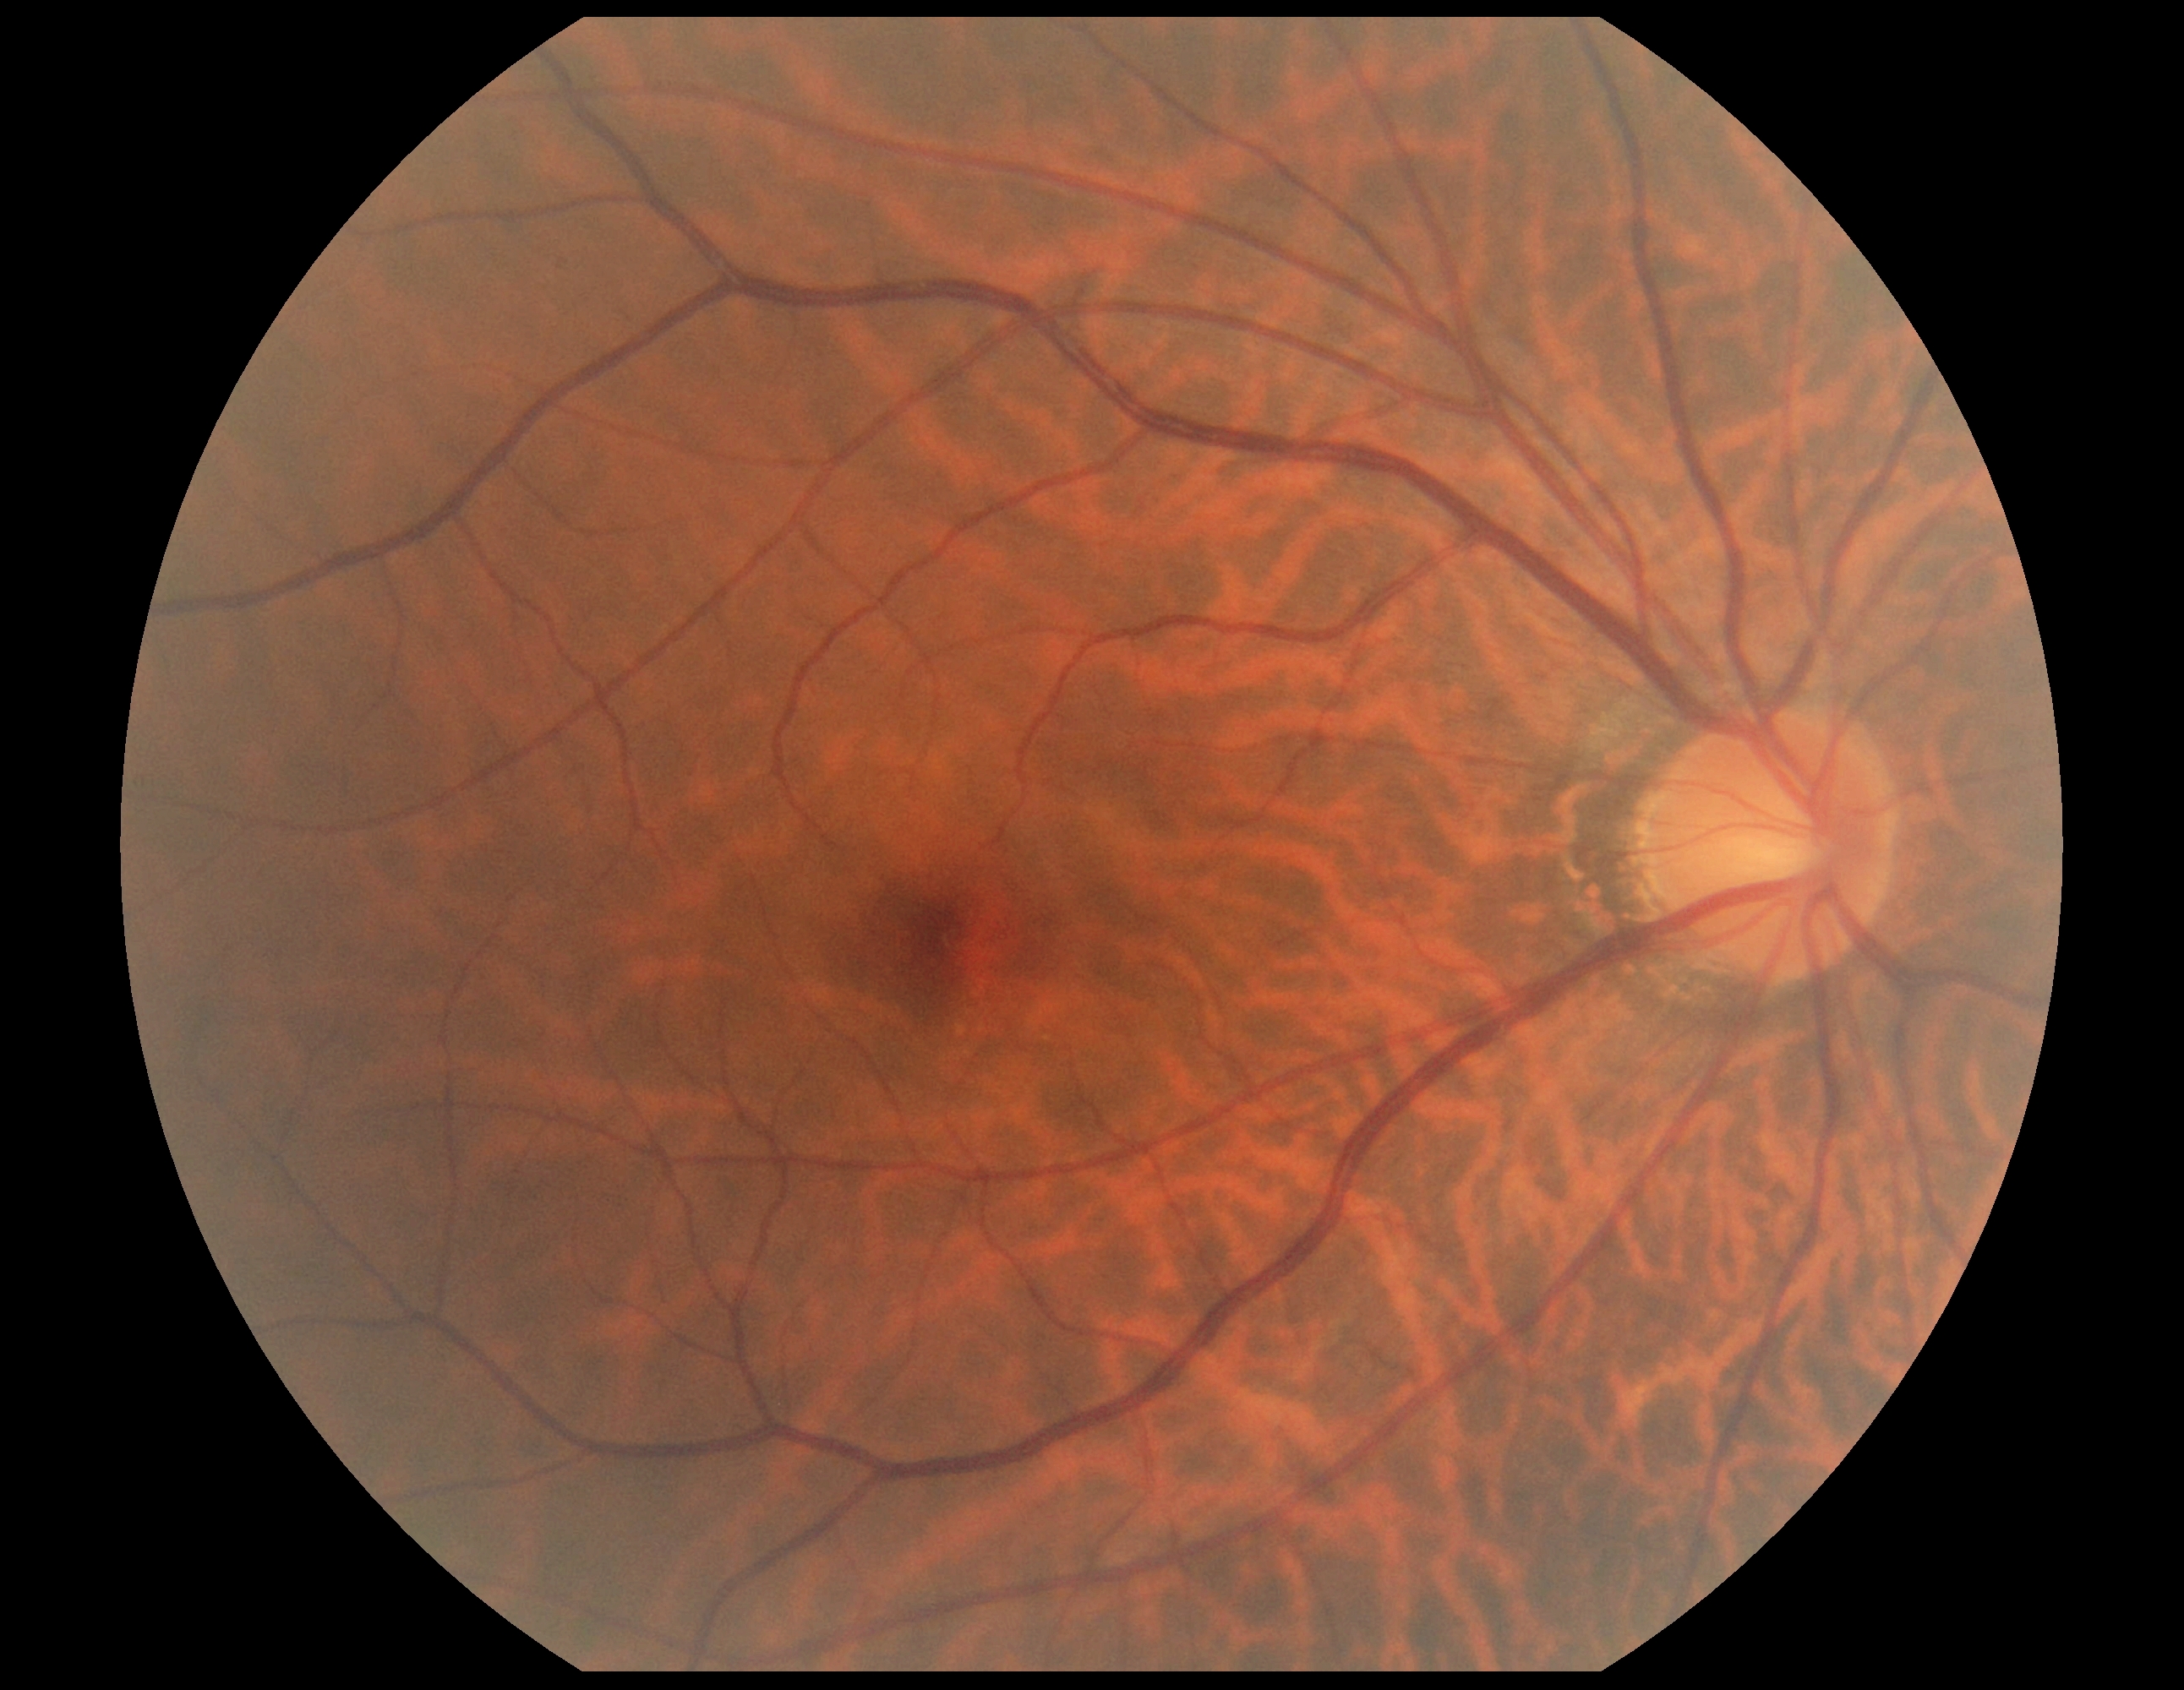
No apparent diabetic retinopathy. DR stage: no apparent diabetic retinopathy (grade 0) — no visible signs of diabetic retinopathy.